45° FOV · NIDEK AFC-230 fundus camera · image size 848x848.
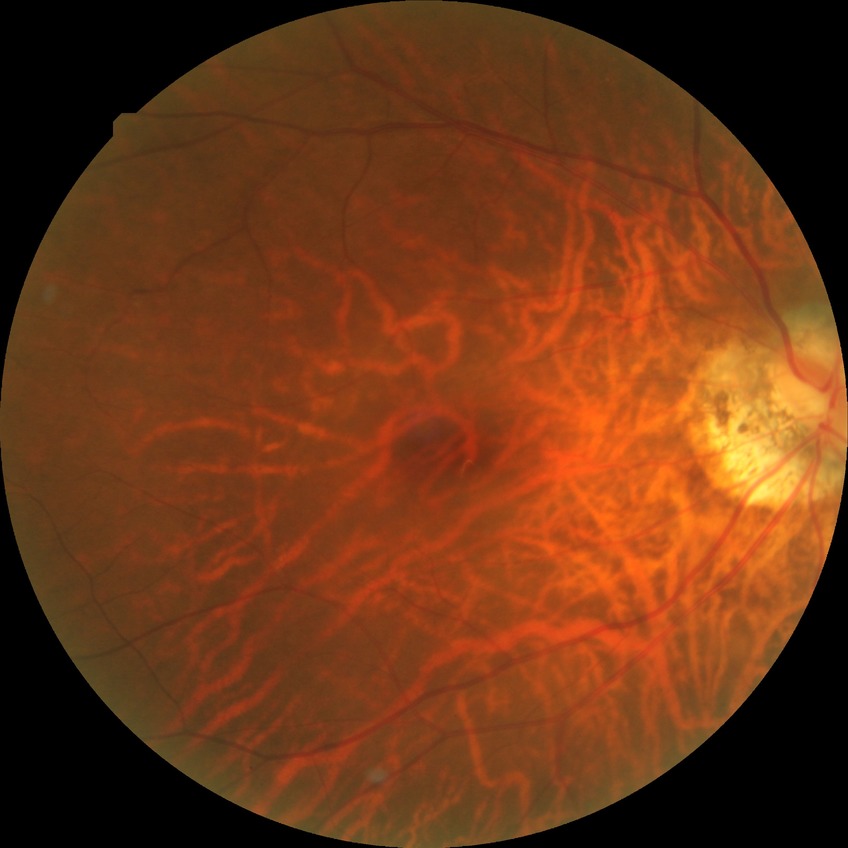
Davis grading: simple diabetic retinopathy.